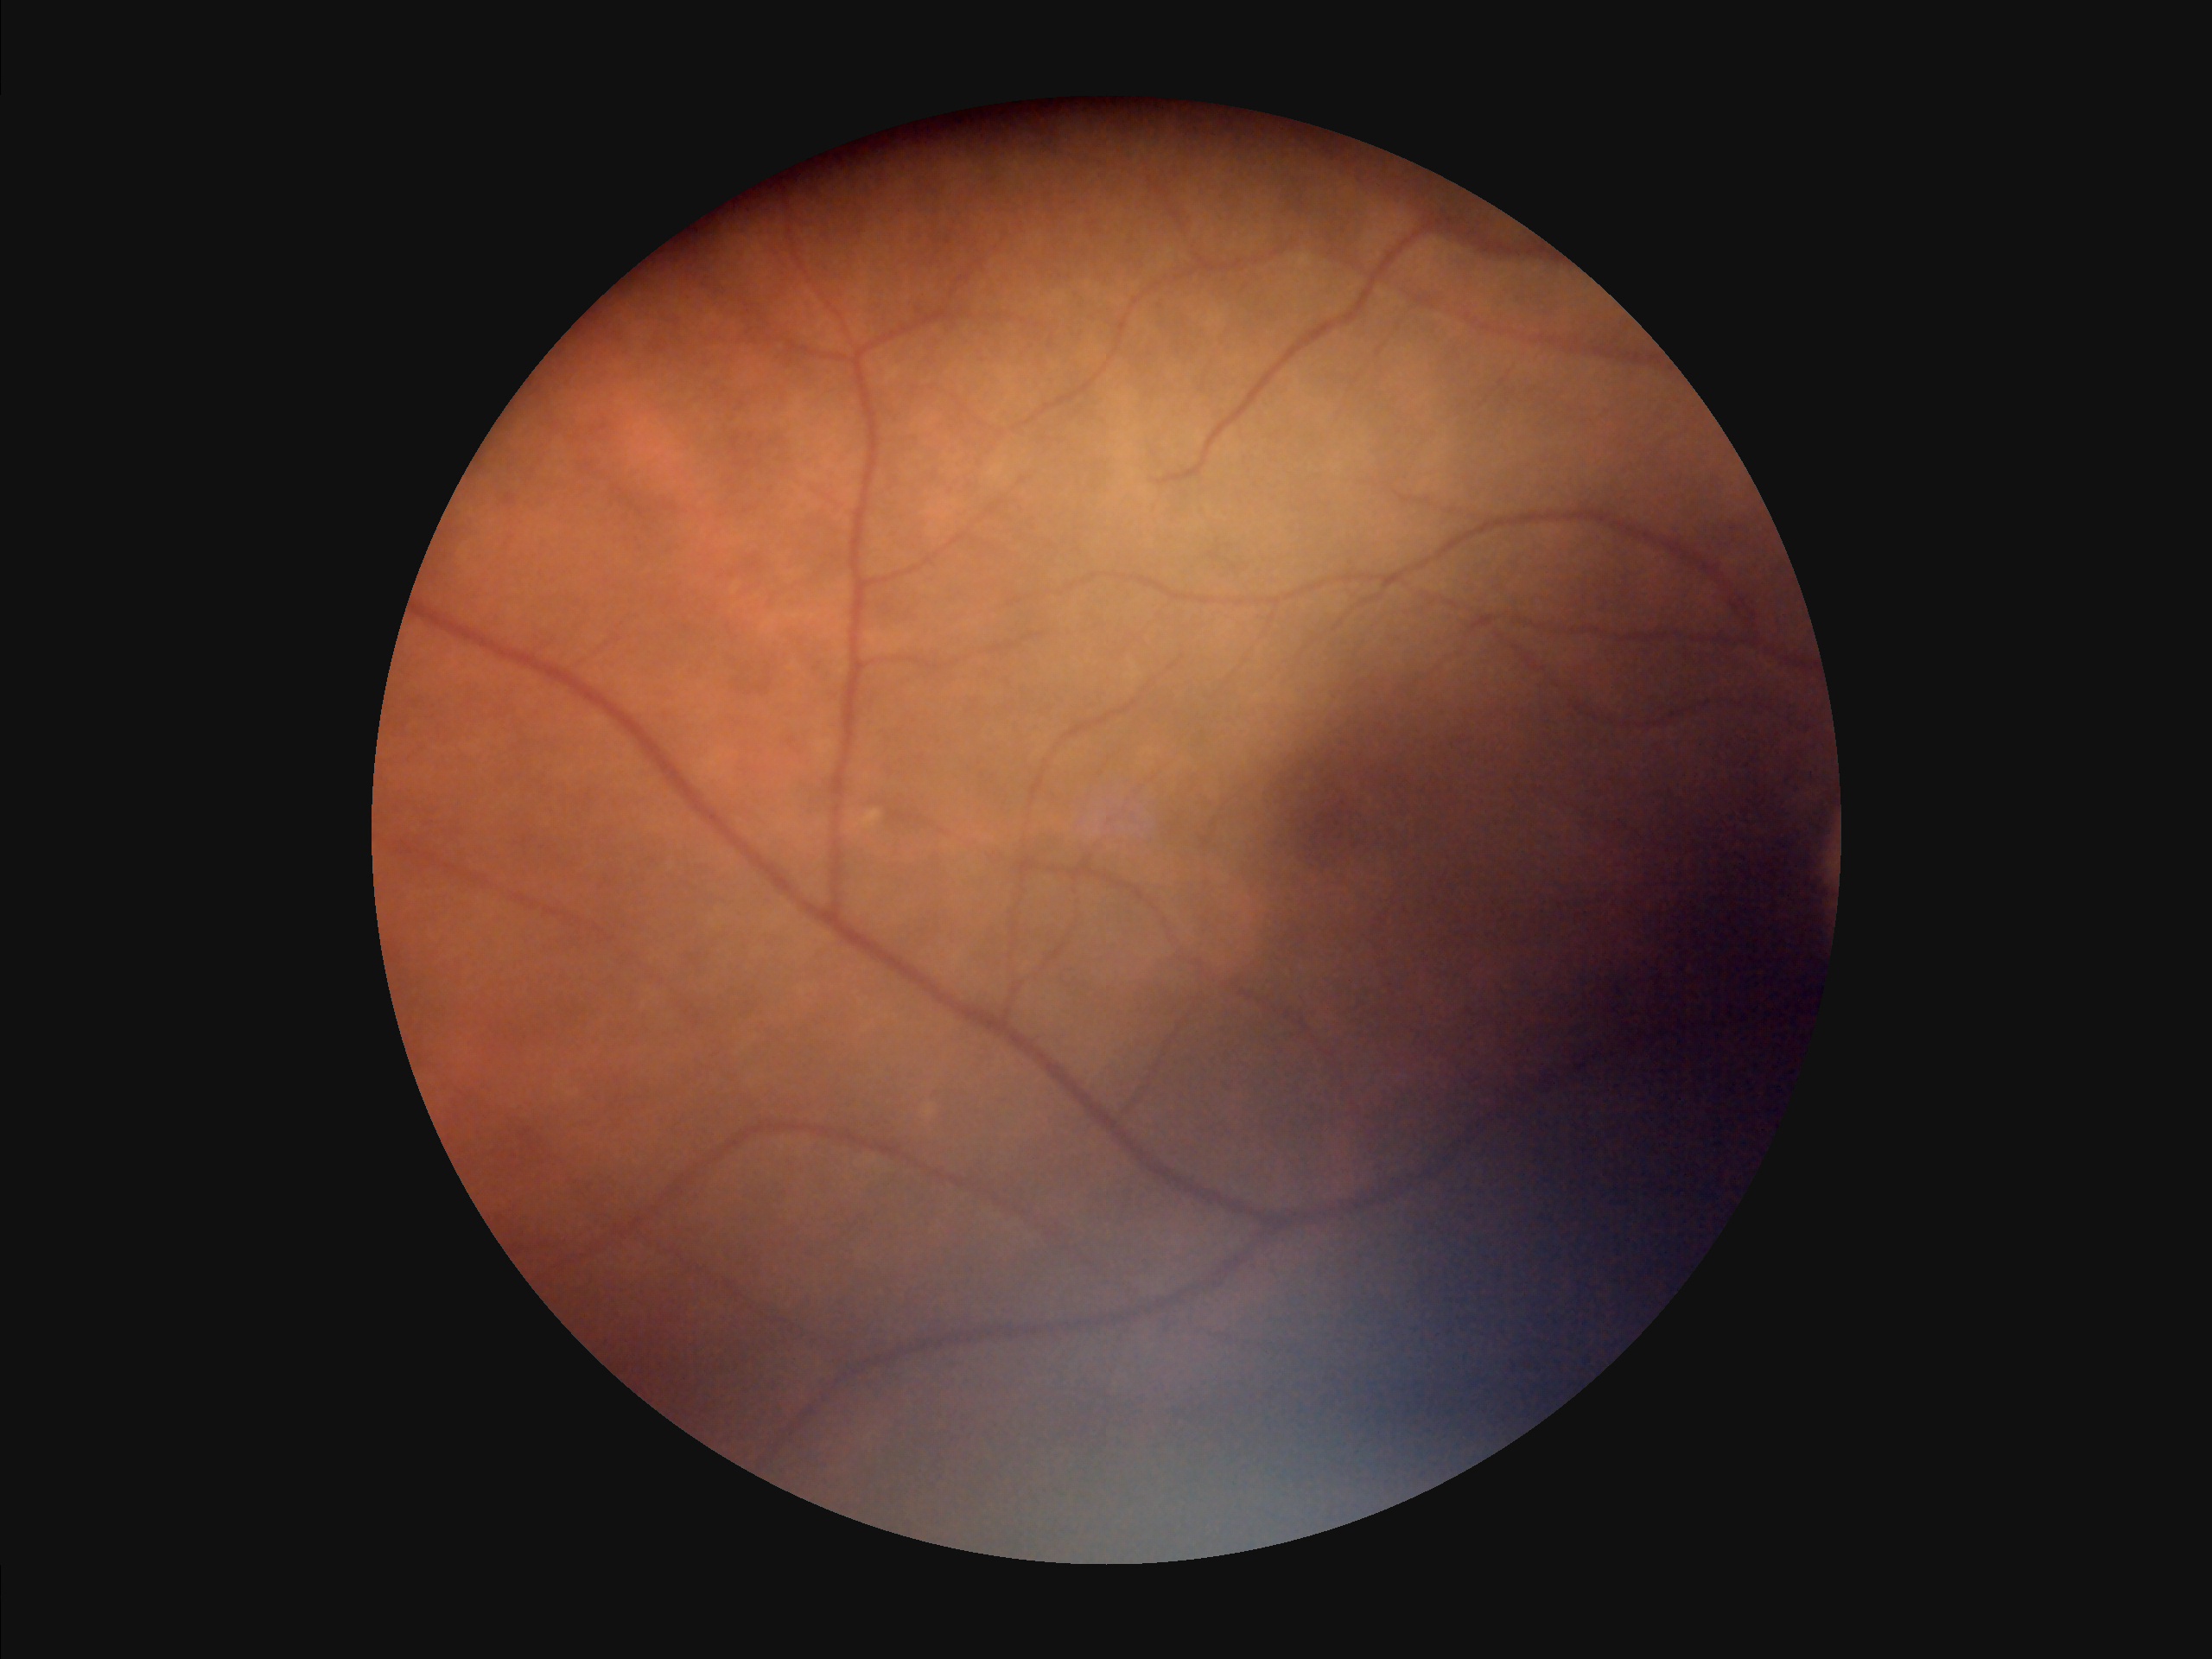
Image quality assessment: overall: inadequate | illumination: poor | sharpness: in focus | contrast: good.